1659x2212, captured on a Remidio Fundus on Phone:
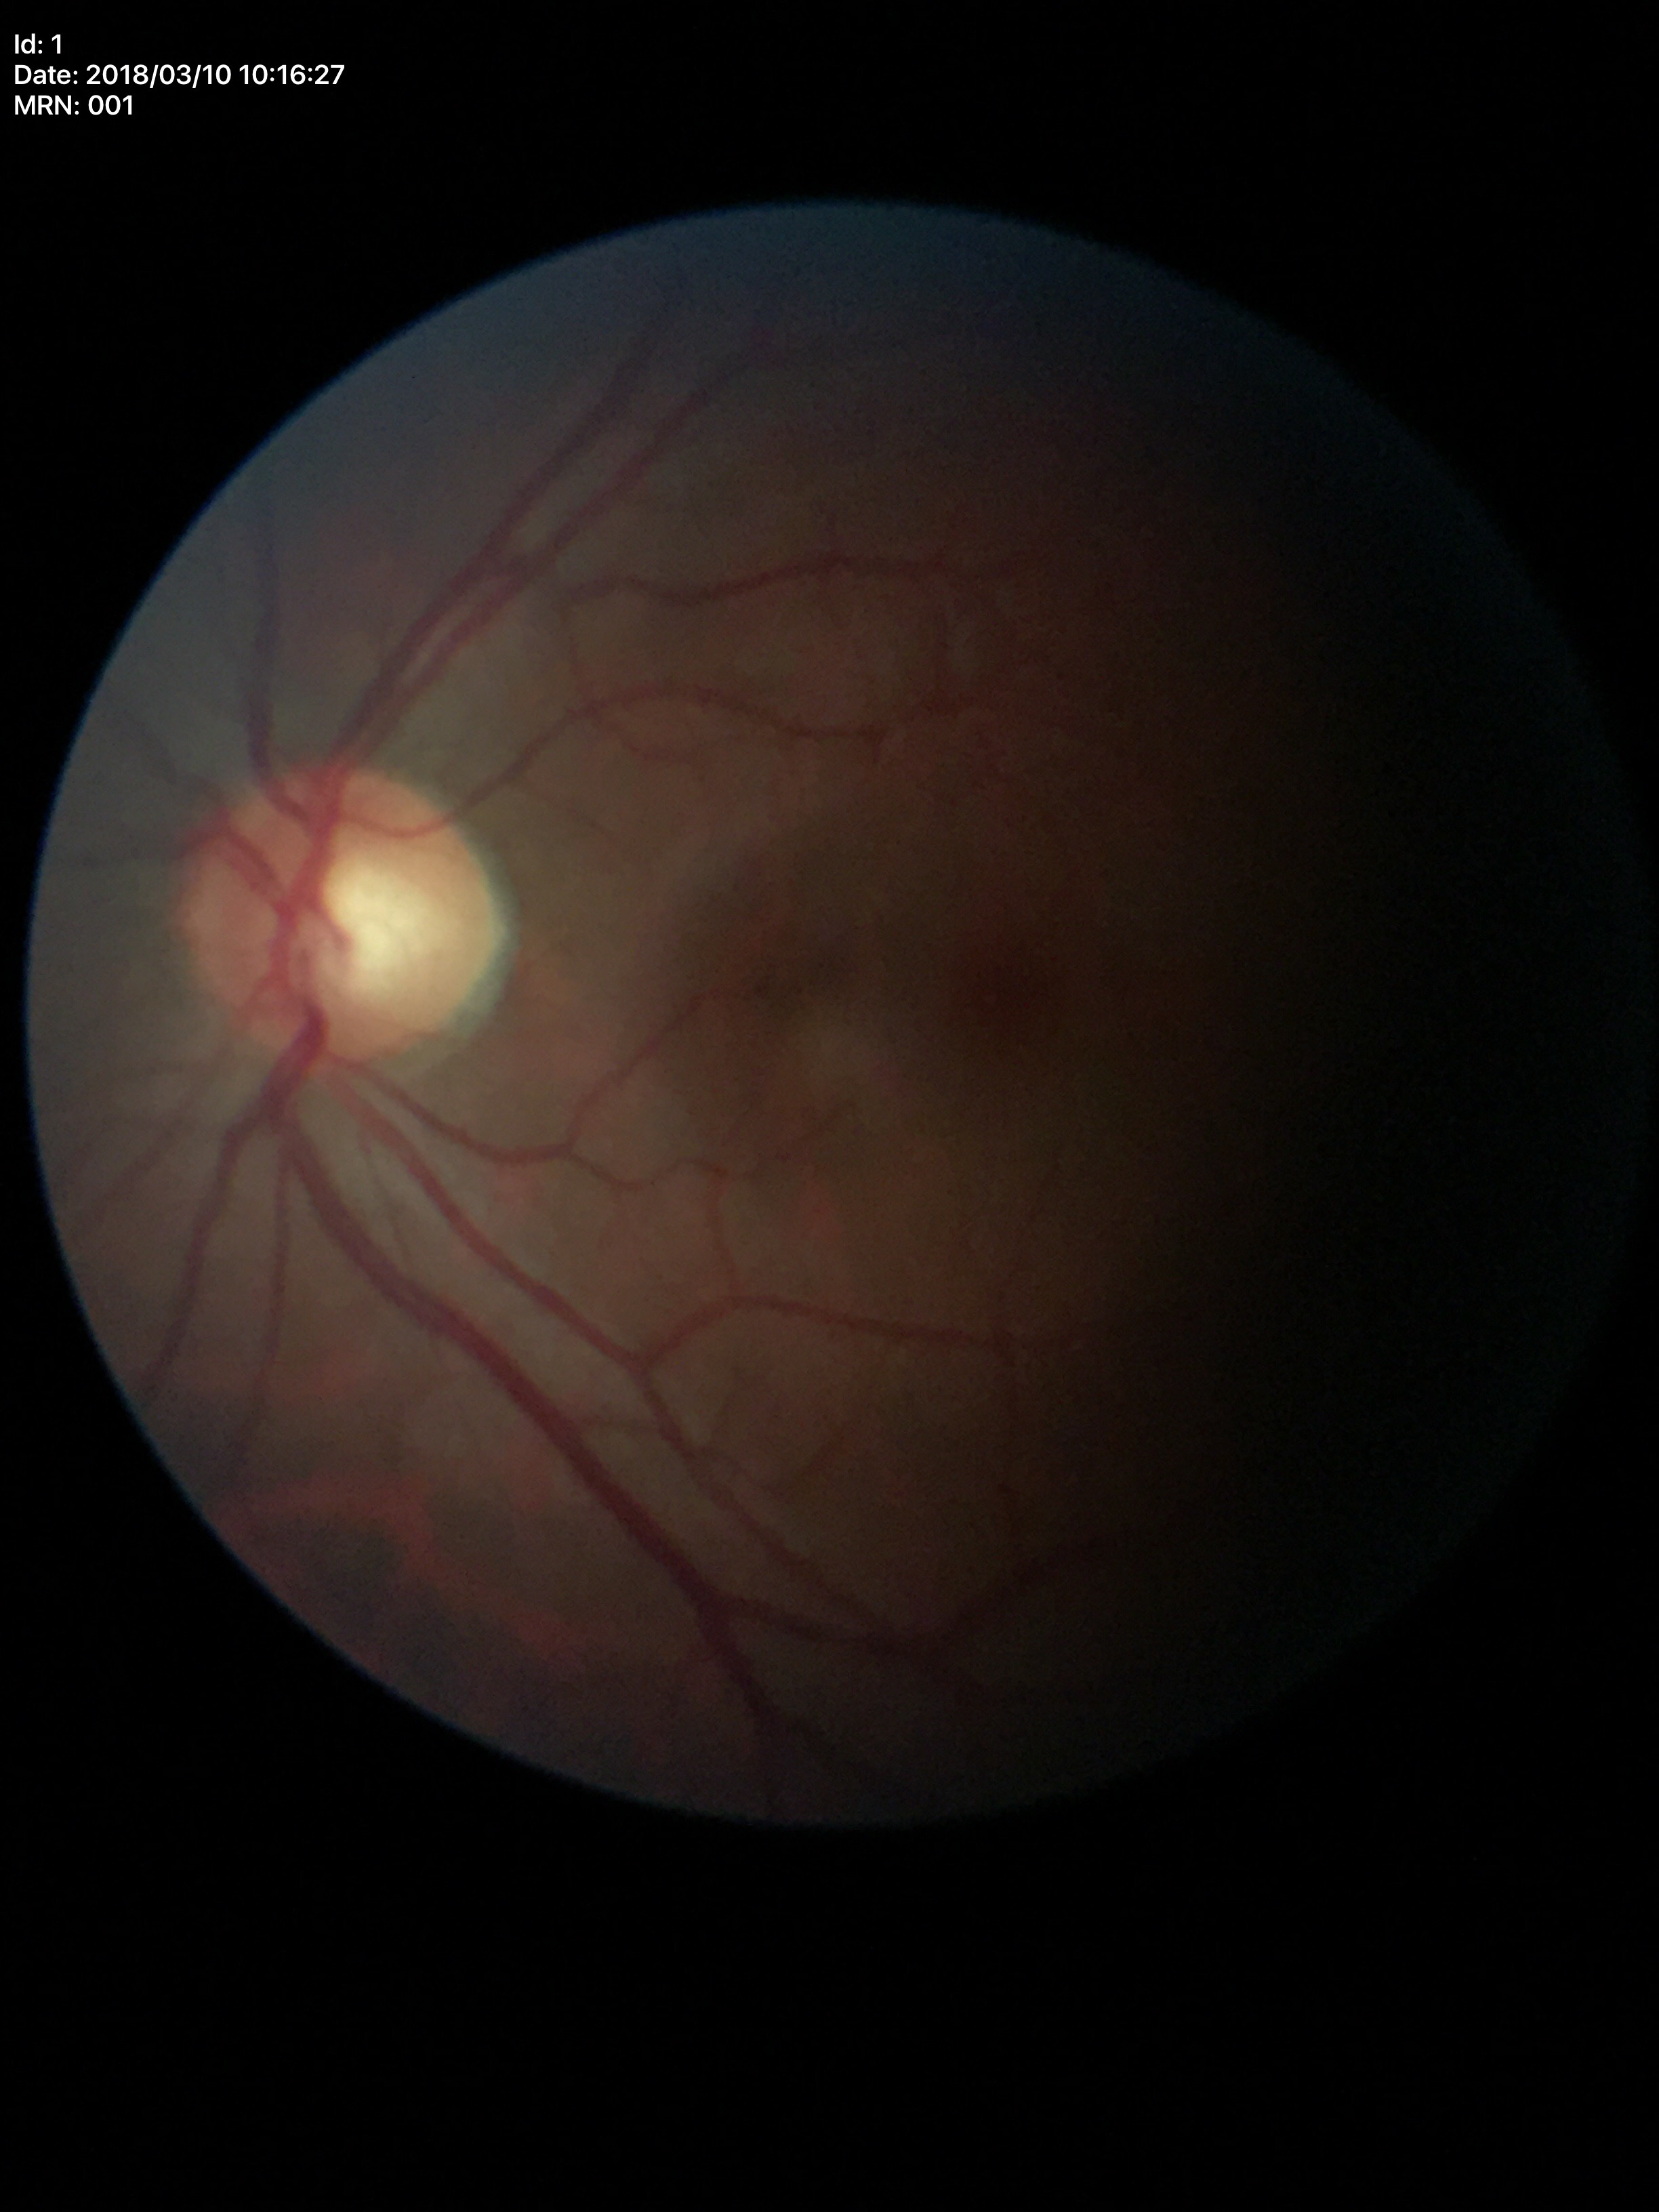

Glaucoma assessment: not suspect.
Vertical CDR of 0.54.
Horizontal cup-to-disc ratio: 0.53.